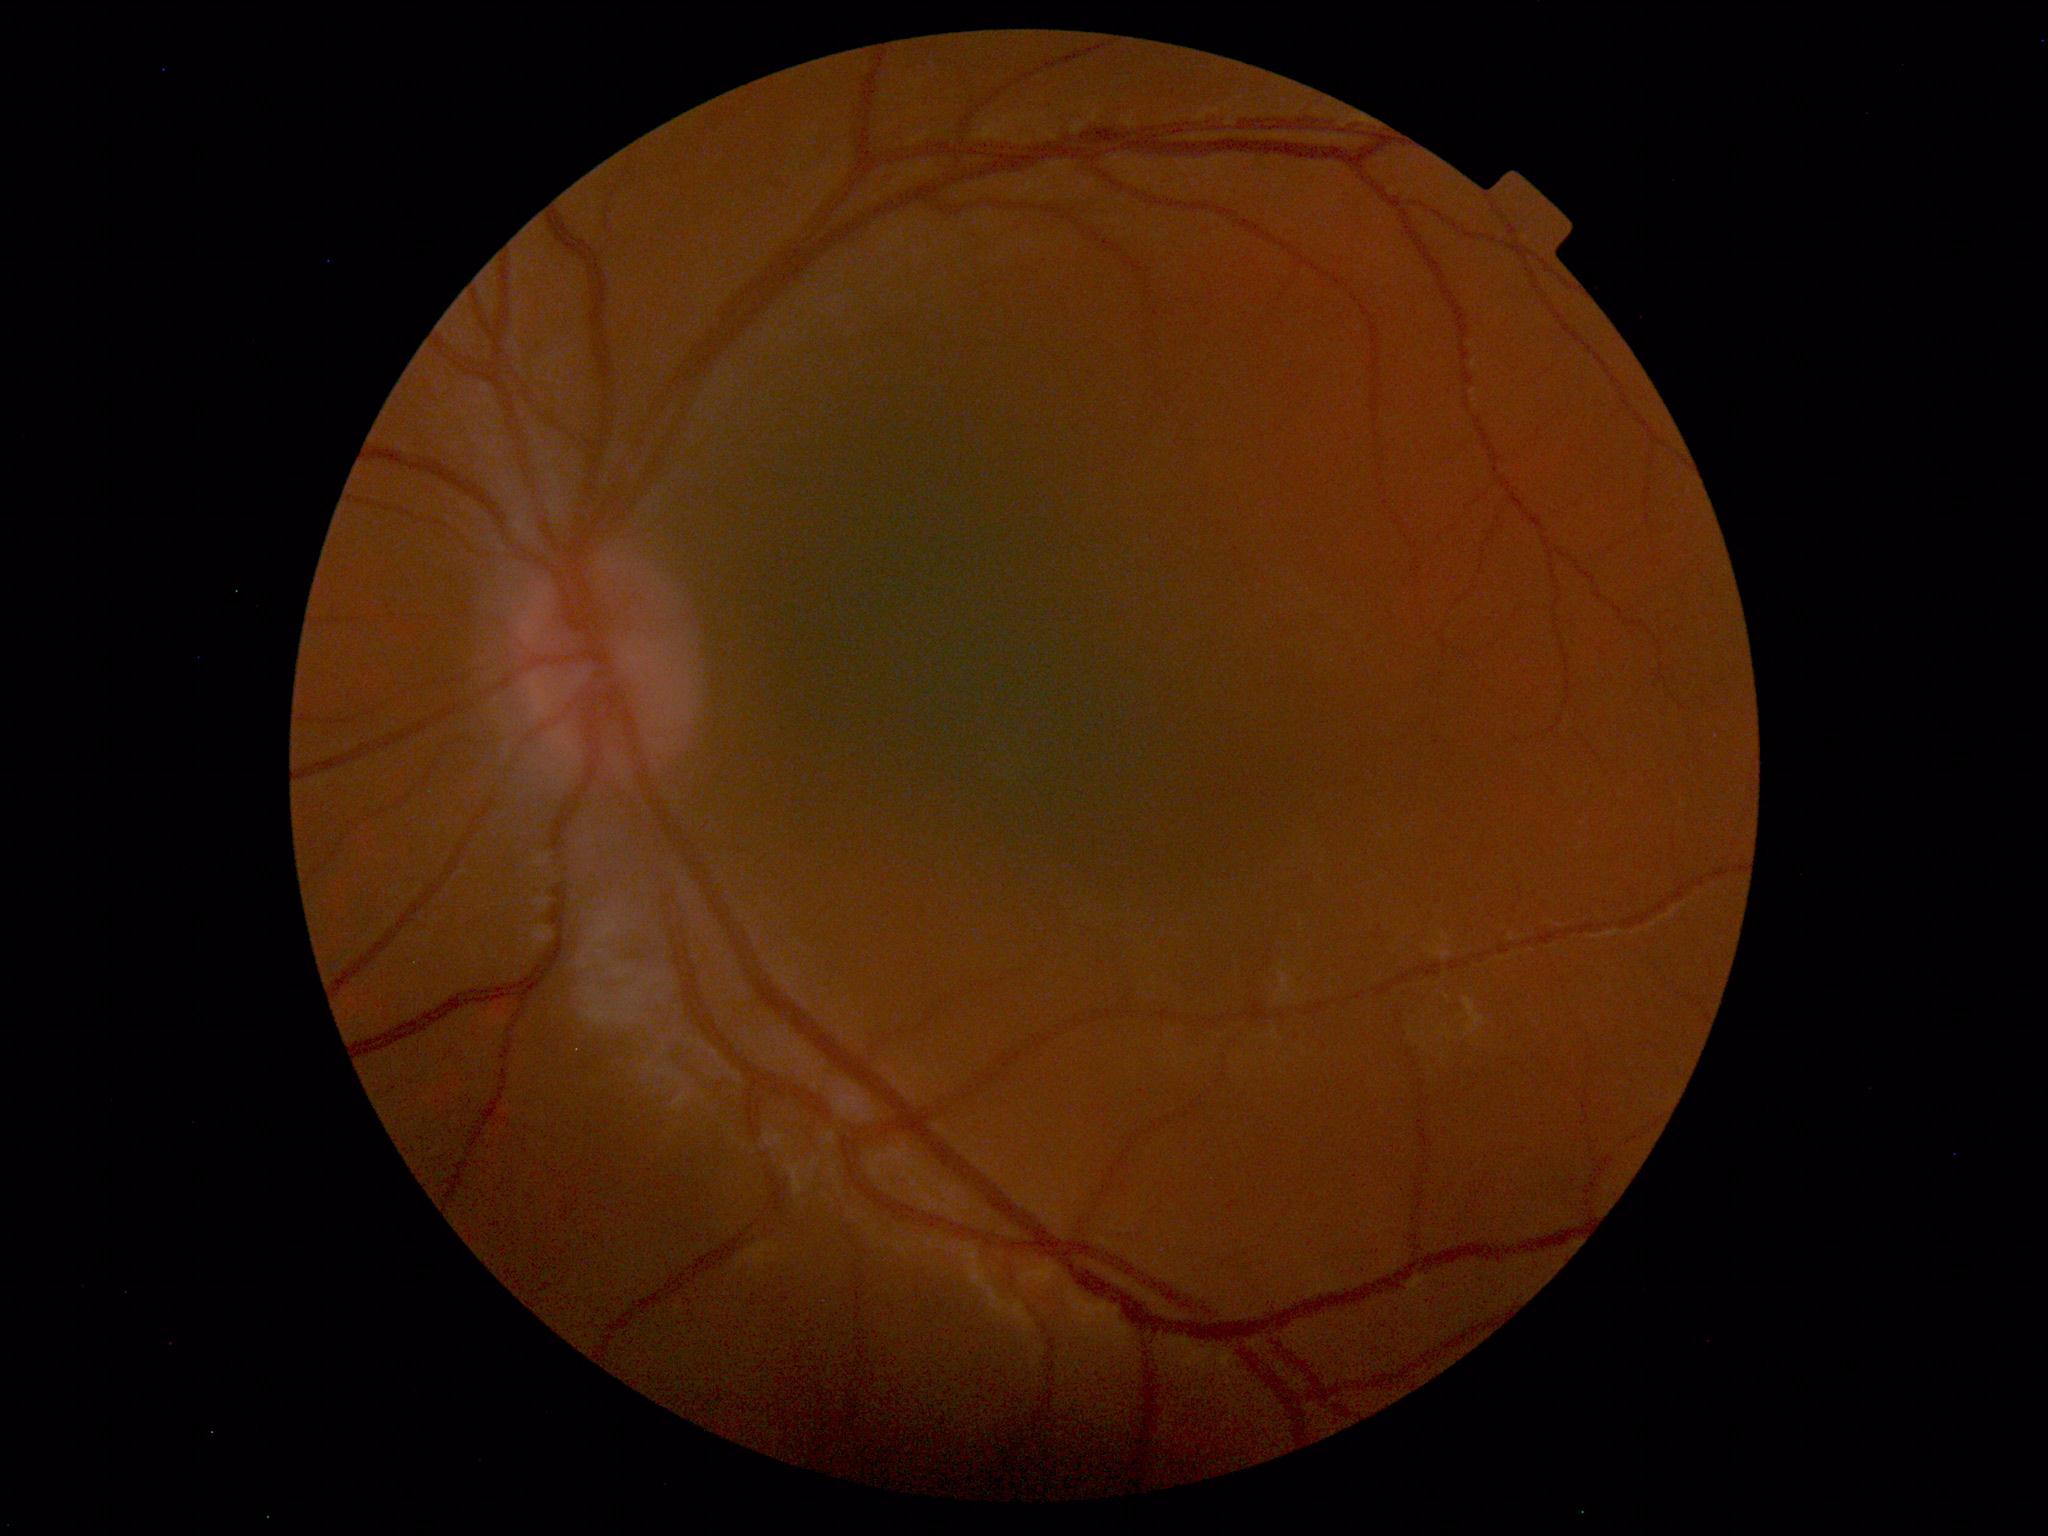 Normal fundus. No pathology identified.